640 x 480 pixels. Infant wide-field fundus photograph — 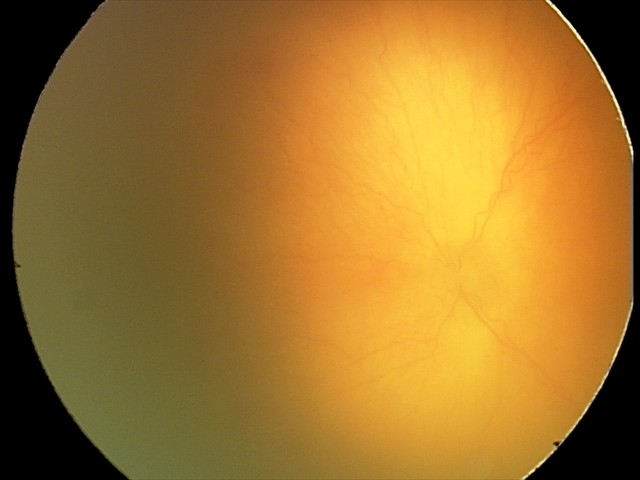

Plus disease was diagnosed.
Series diagnosed as aggressive ROP (A-ROP).